2212x1659px — 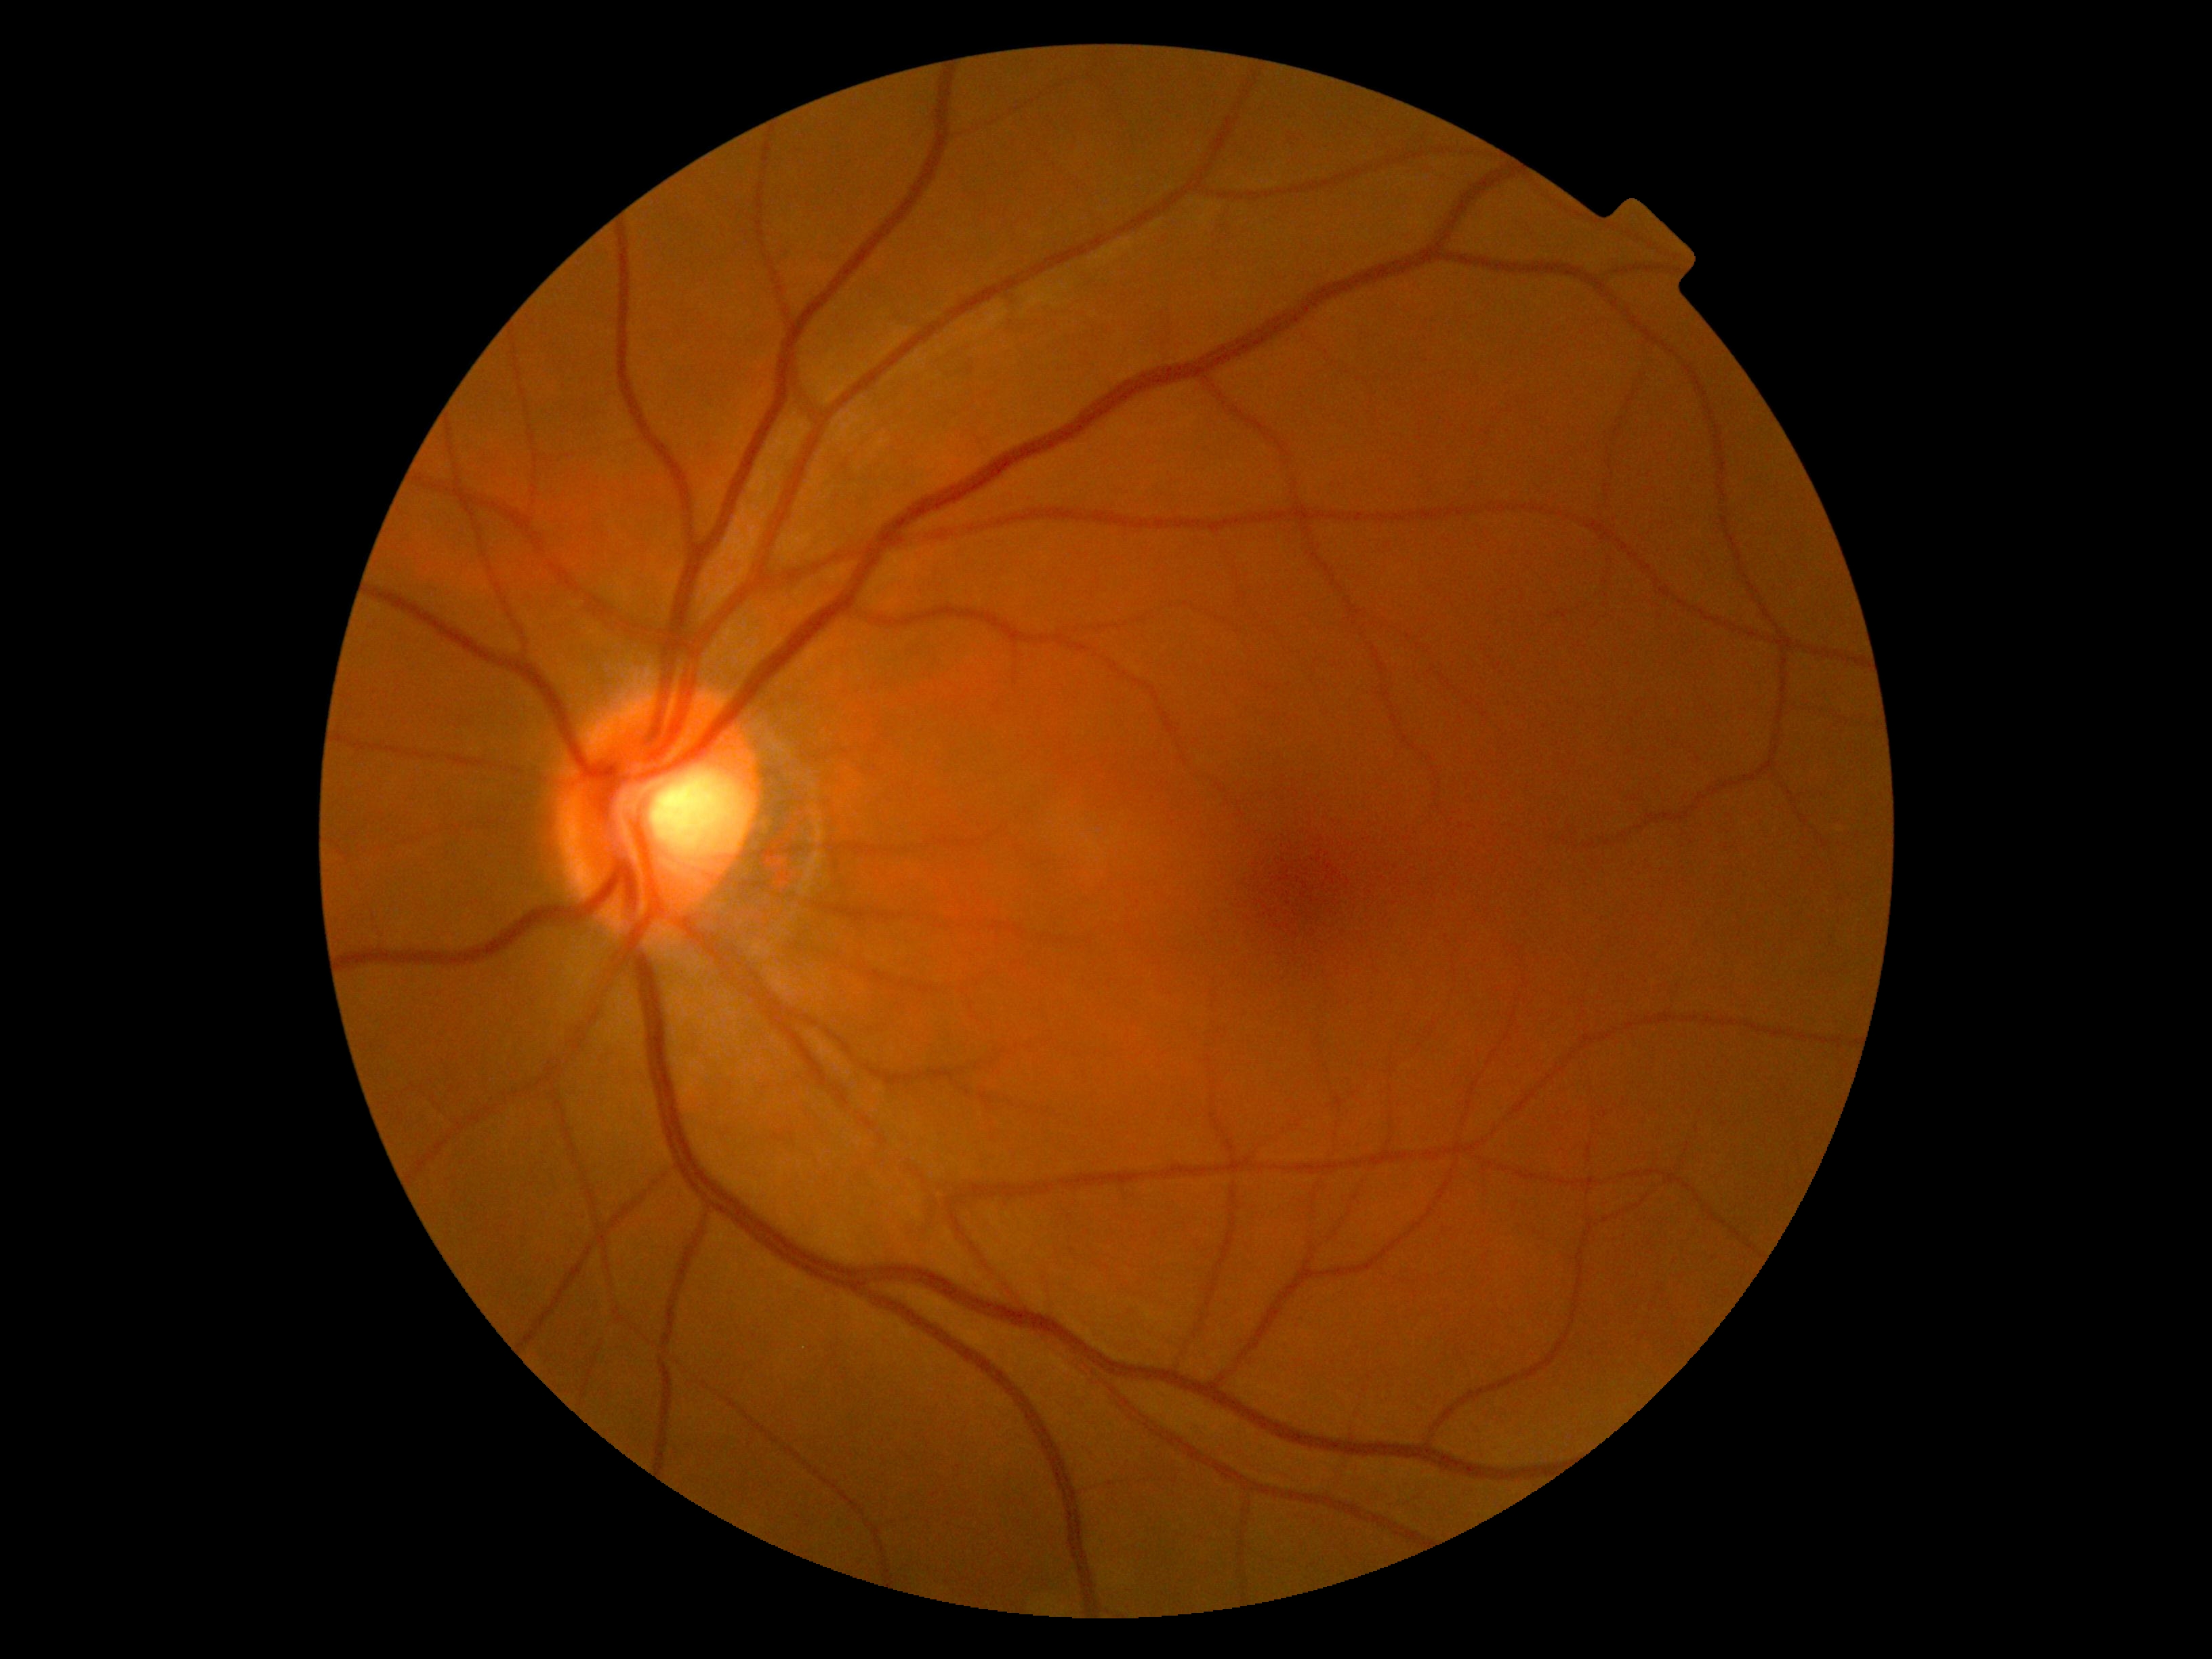 Diabetic retinopathy severity: grade 0.